Wide-field contact fundus photograph of an infant · 1440x1080px:
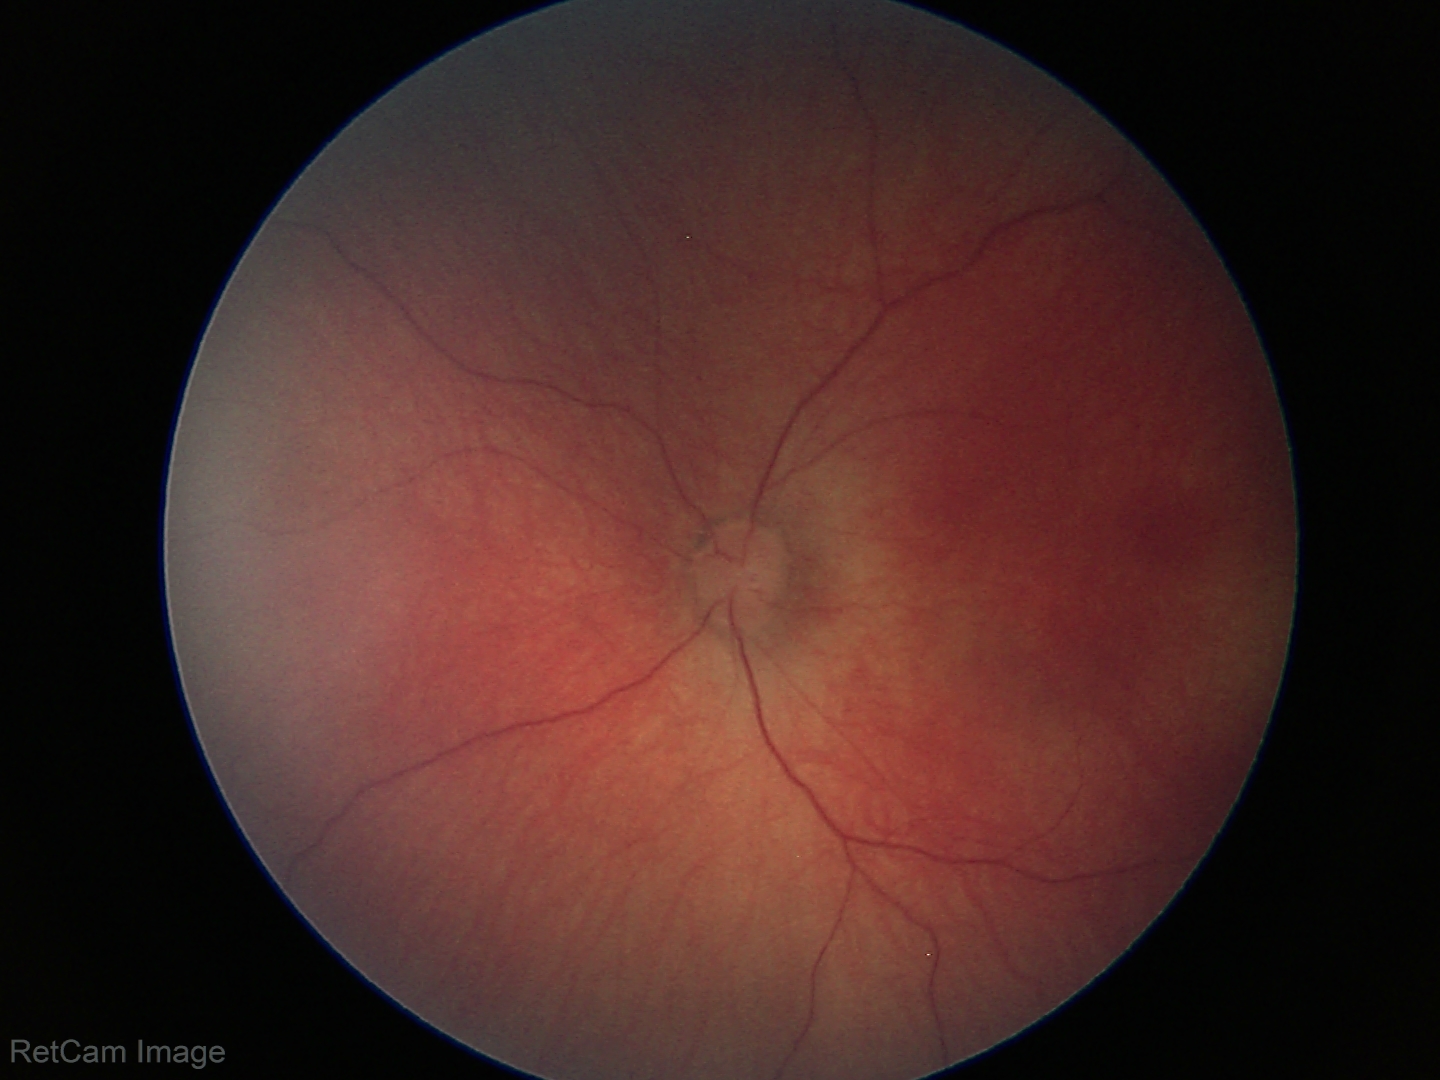
Impression: physiological.